Acquired on the Phoenix ICON. 1240 by 1240 pixels. Wide-field fundus photograph from neonatal ROP screening.
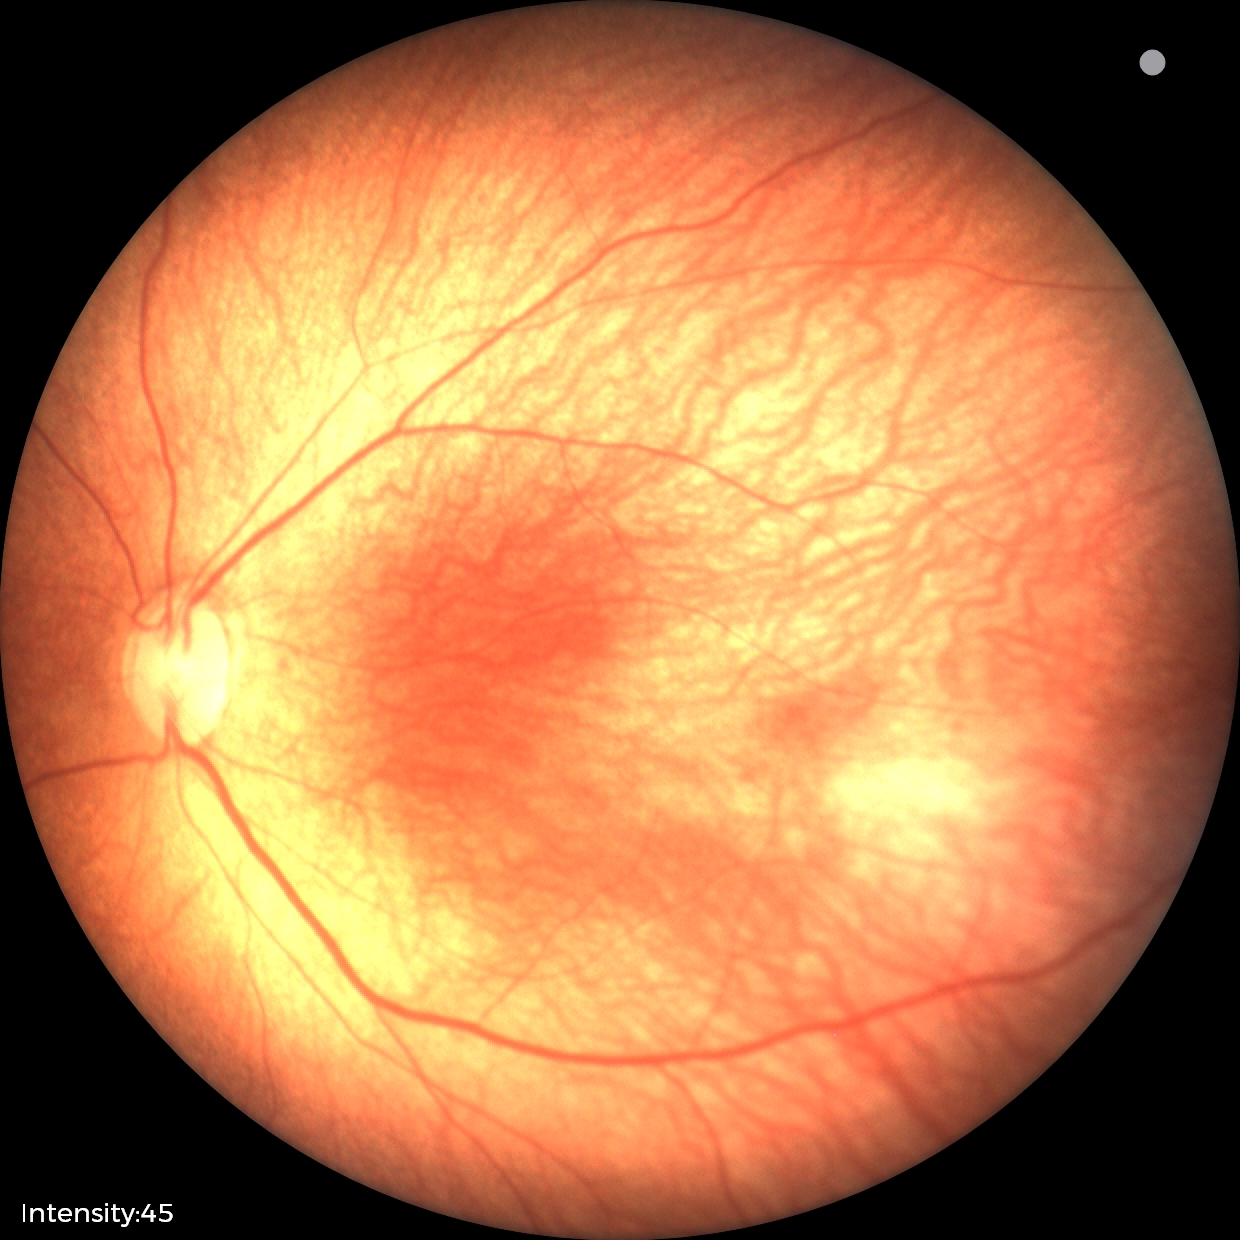
Plus disease absent.
Series diagnosed as retinopathy of prematurity stage 1.